Nonmydriatic fundus photograph · NIDEK AFC-230 fundus camera · FOV: 45 degrees · retinal fundus photograph · 848x848: 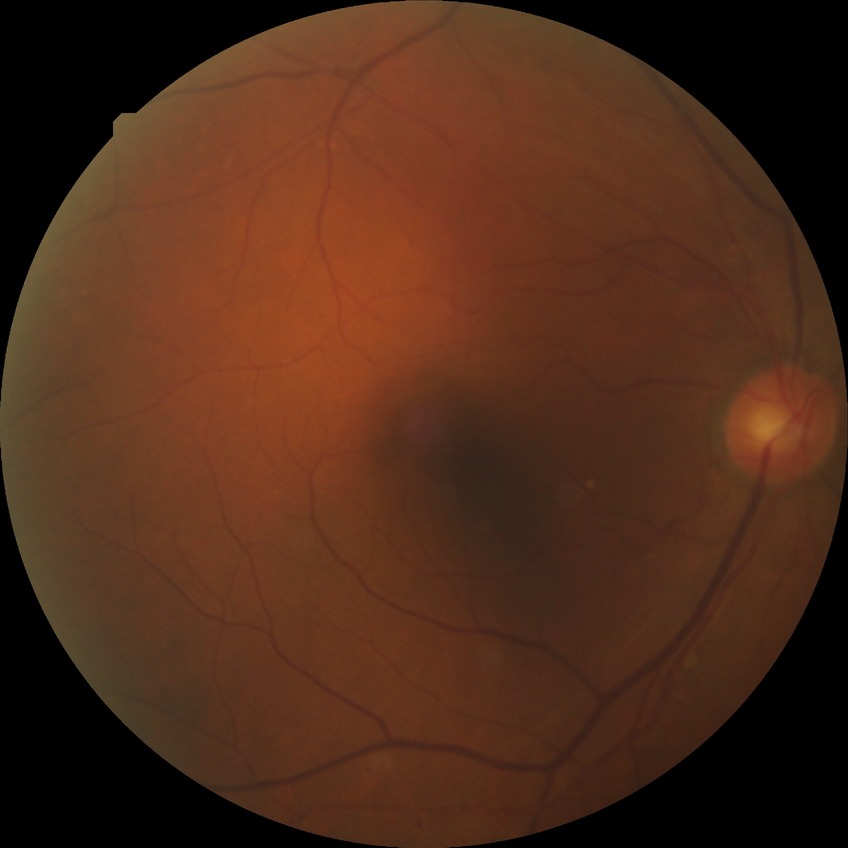 Davis grading is simple diabetic retinopathy.